Color fundus photograph, 1960 x 1897 pixels:
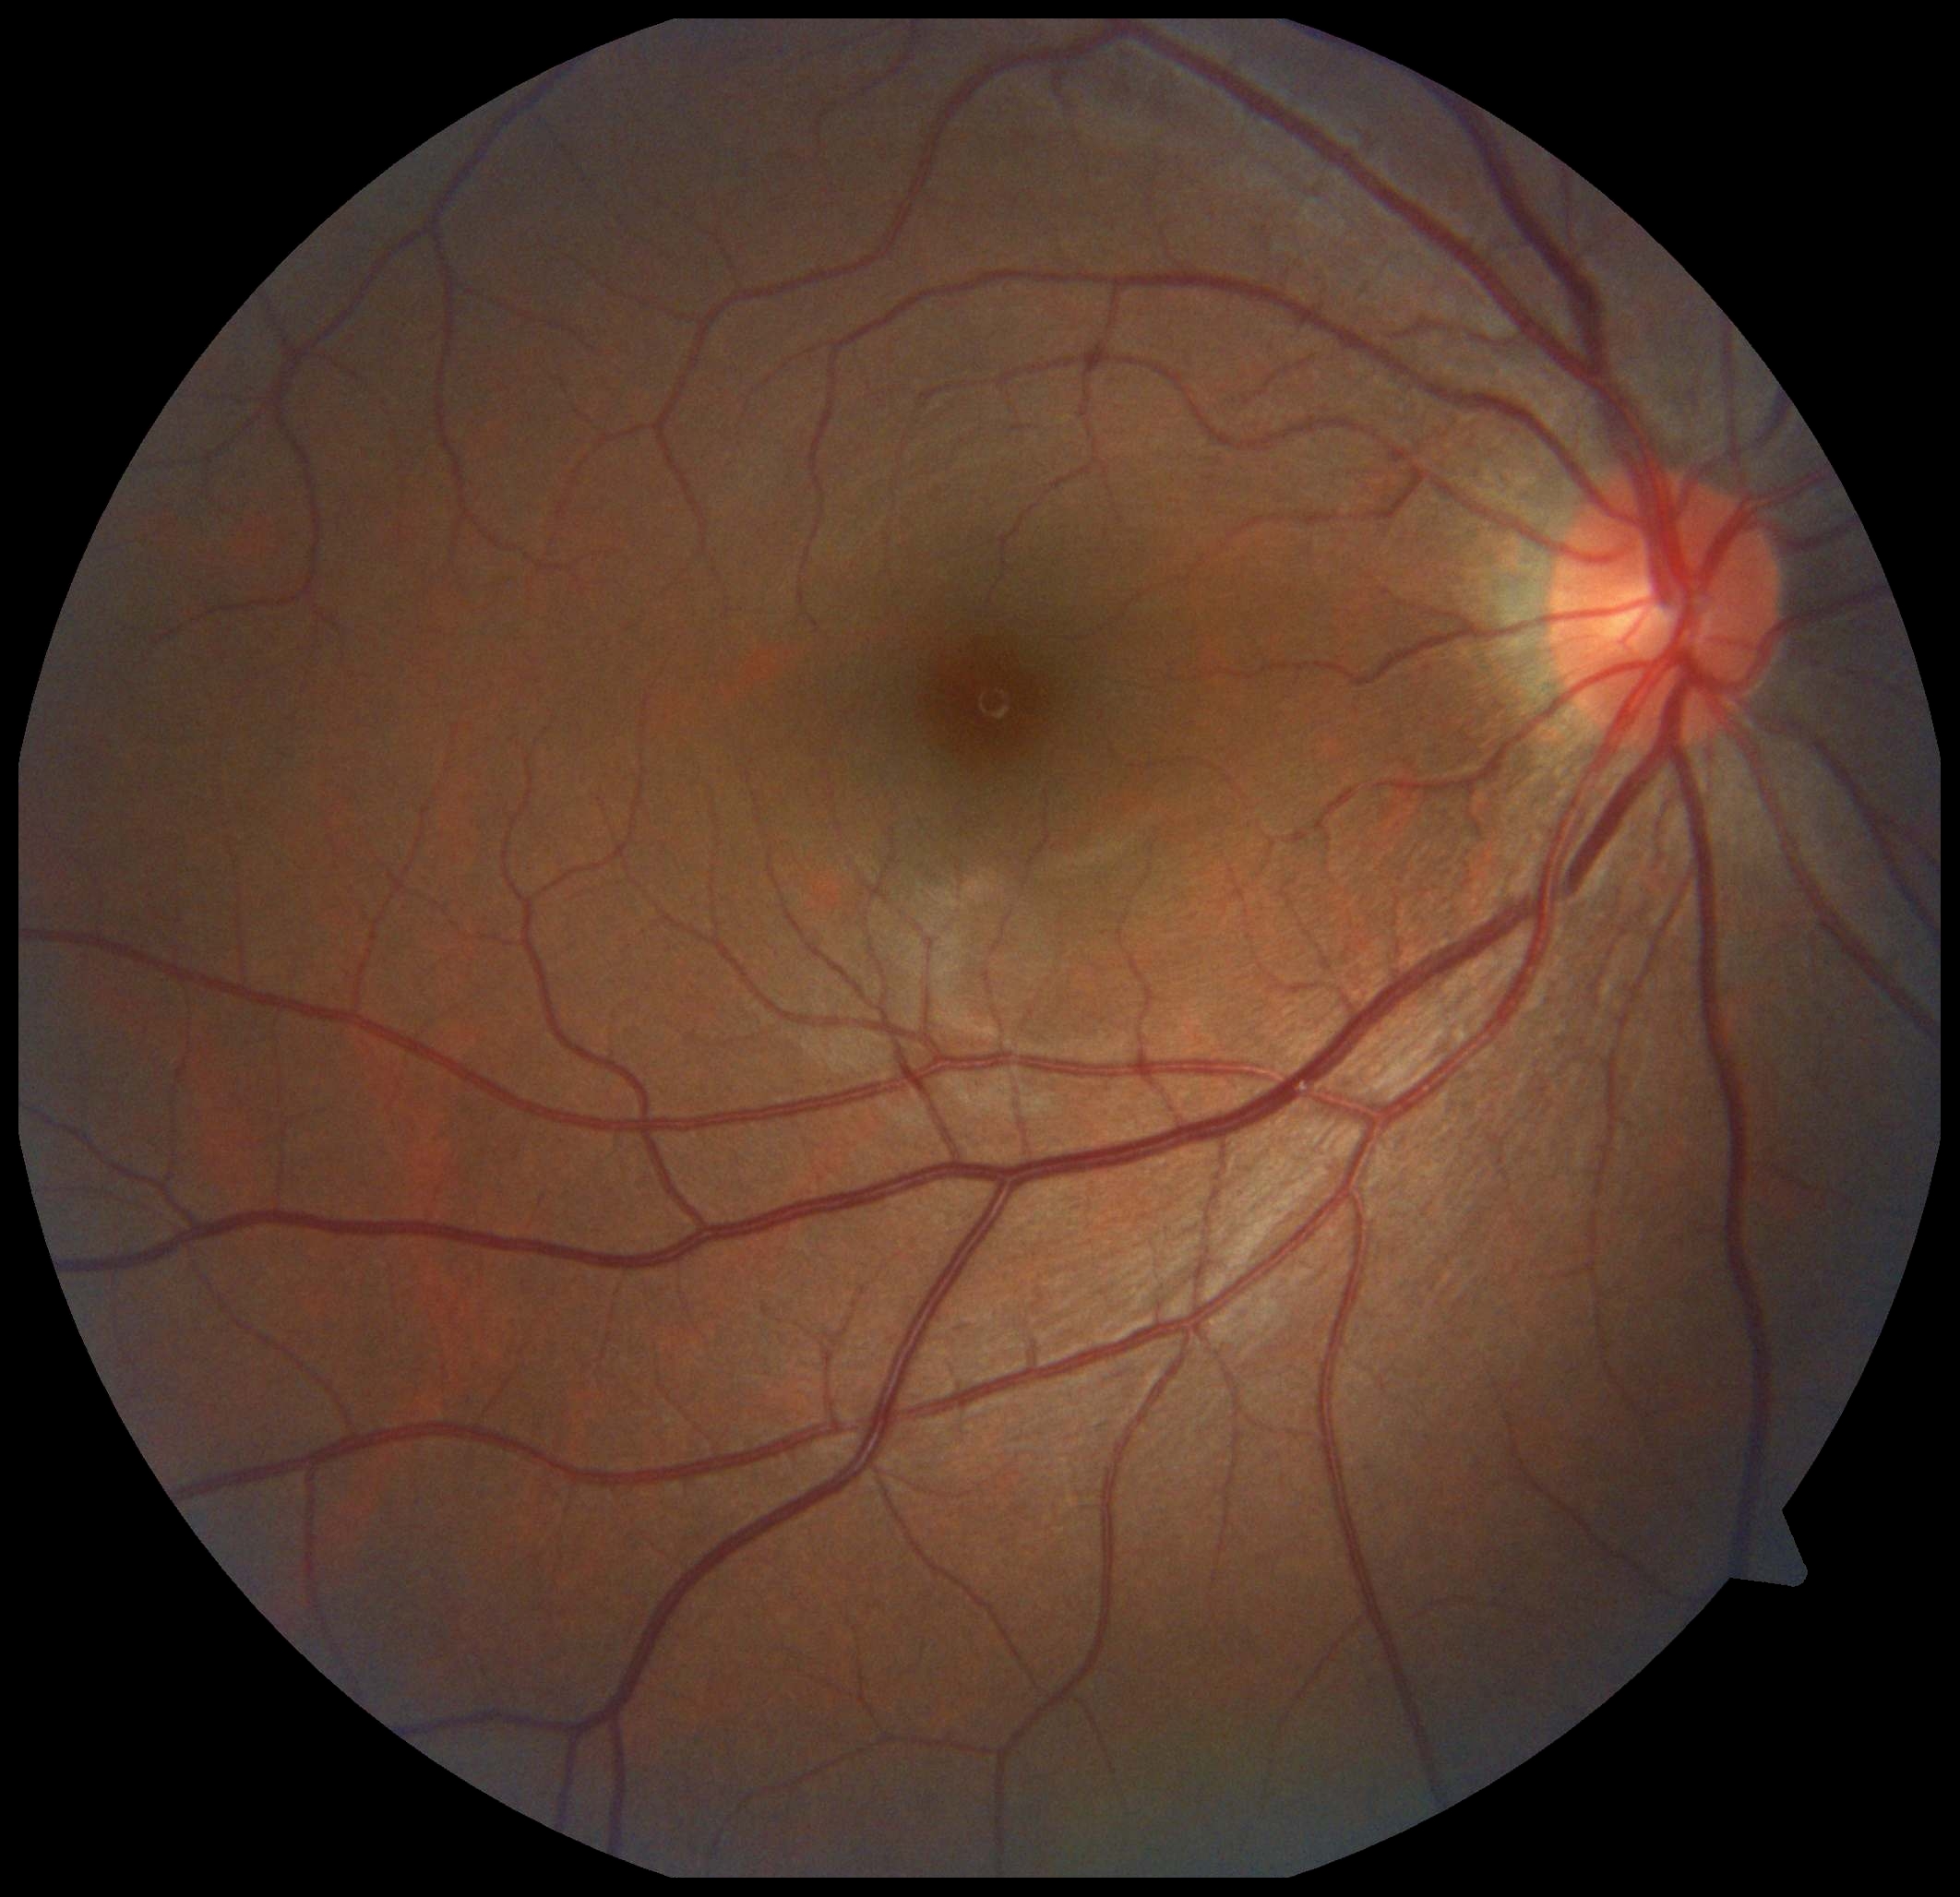

DR grade: 0.